Captured with the Natus RetCam Envision (130° field of view). 1440x1080. Infant wide-field fundus photograph:
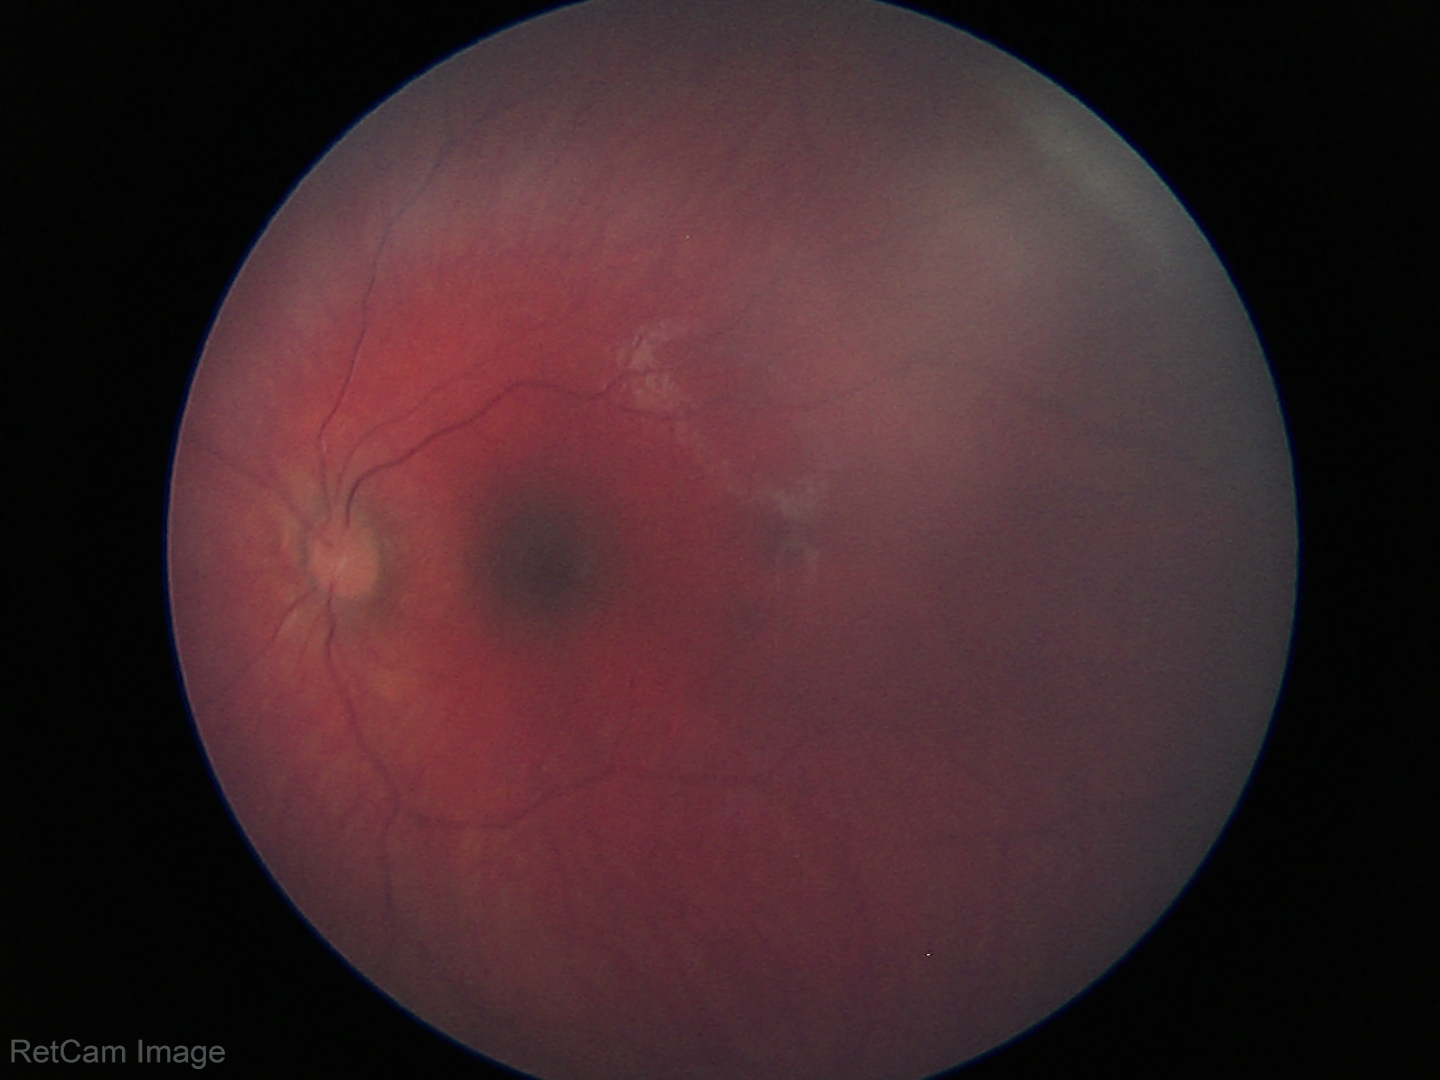 Screening examination with no abnormal retinal findings.